Color fundus photograph:
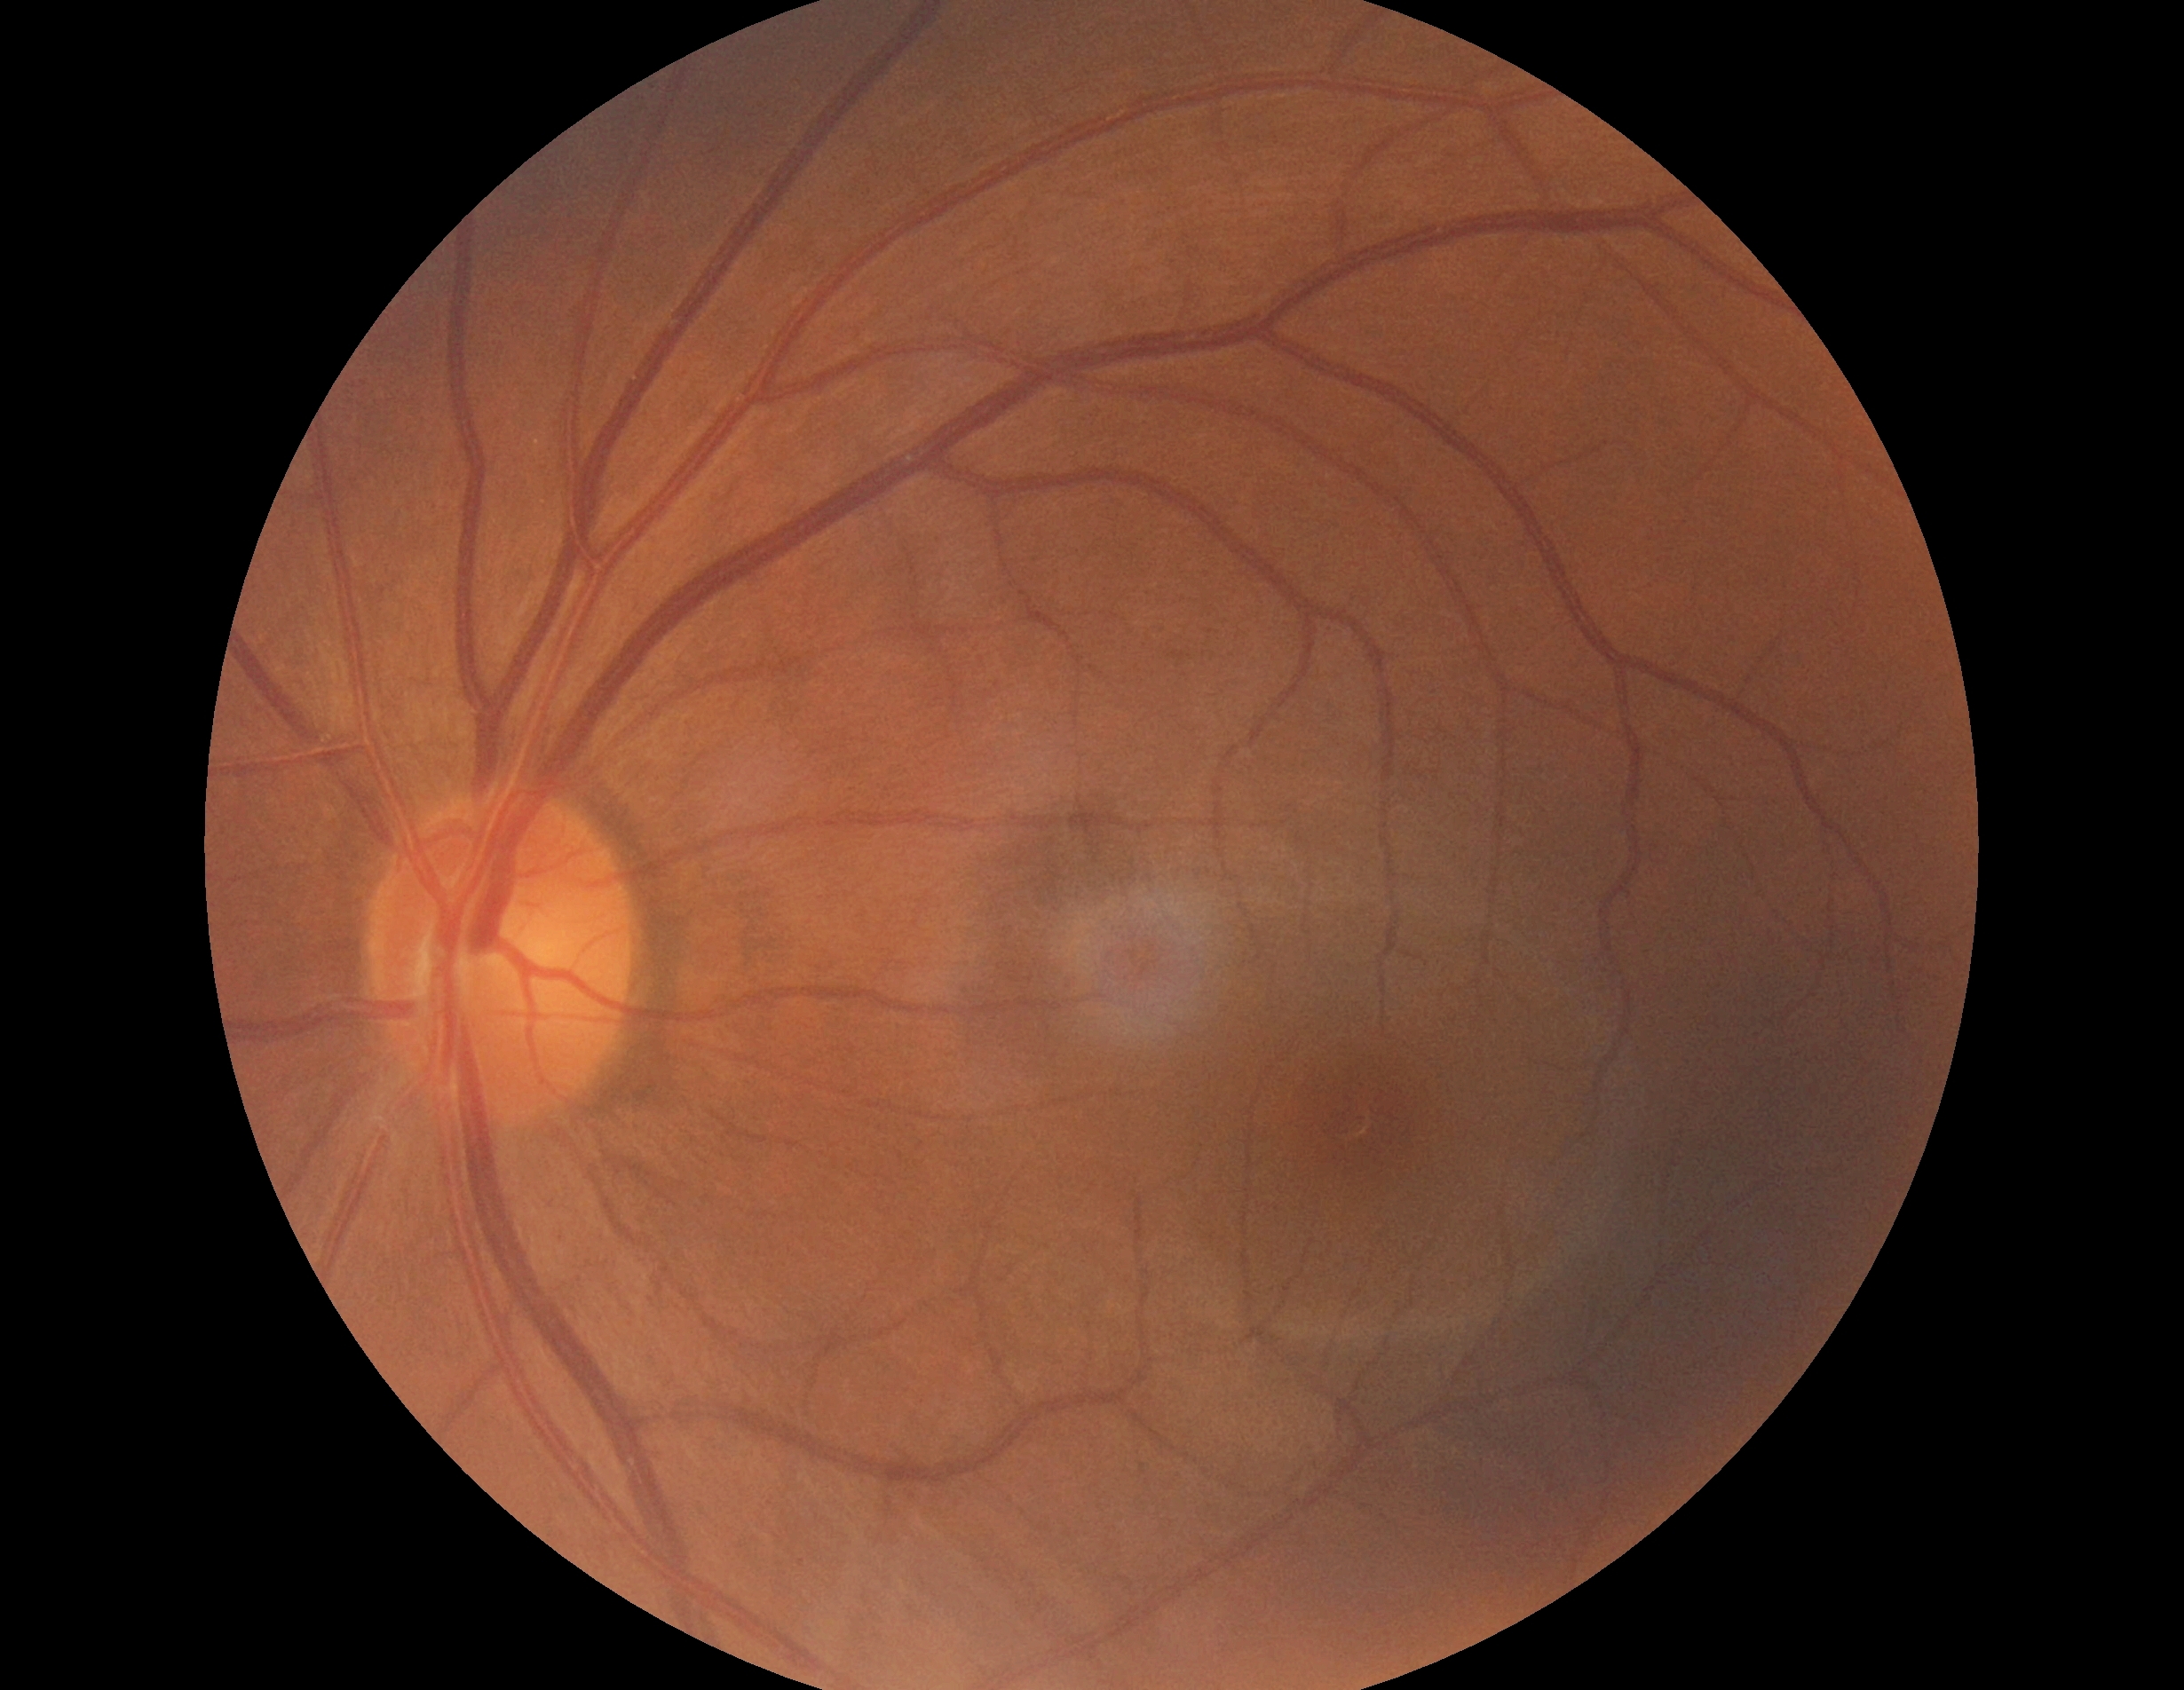
Diabetic retinopathy (DR): no apparent diabetic retinopathy (grade 0) — no visible signs of diabetic retinopathy.